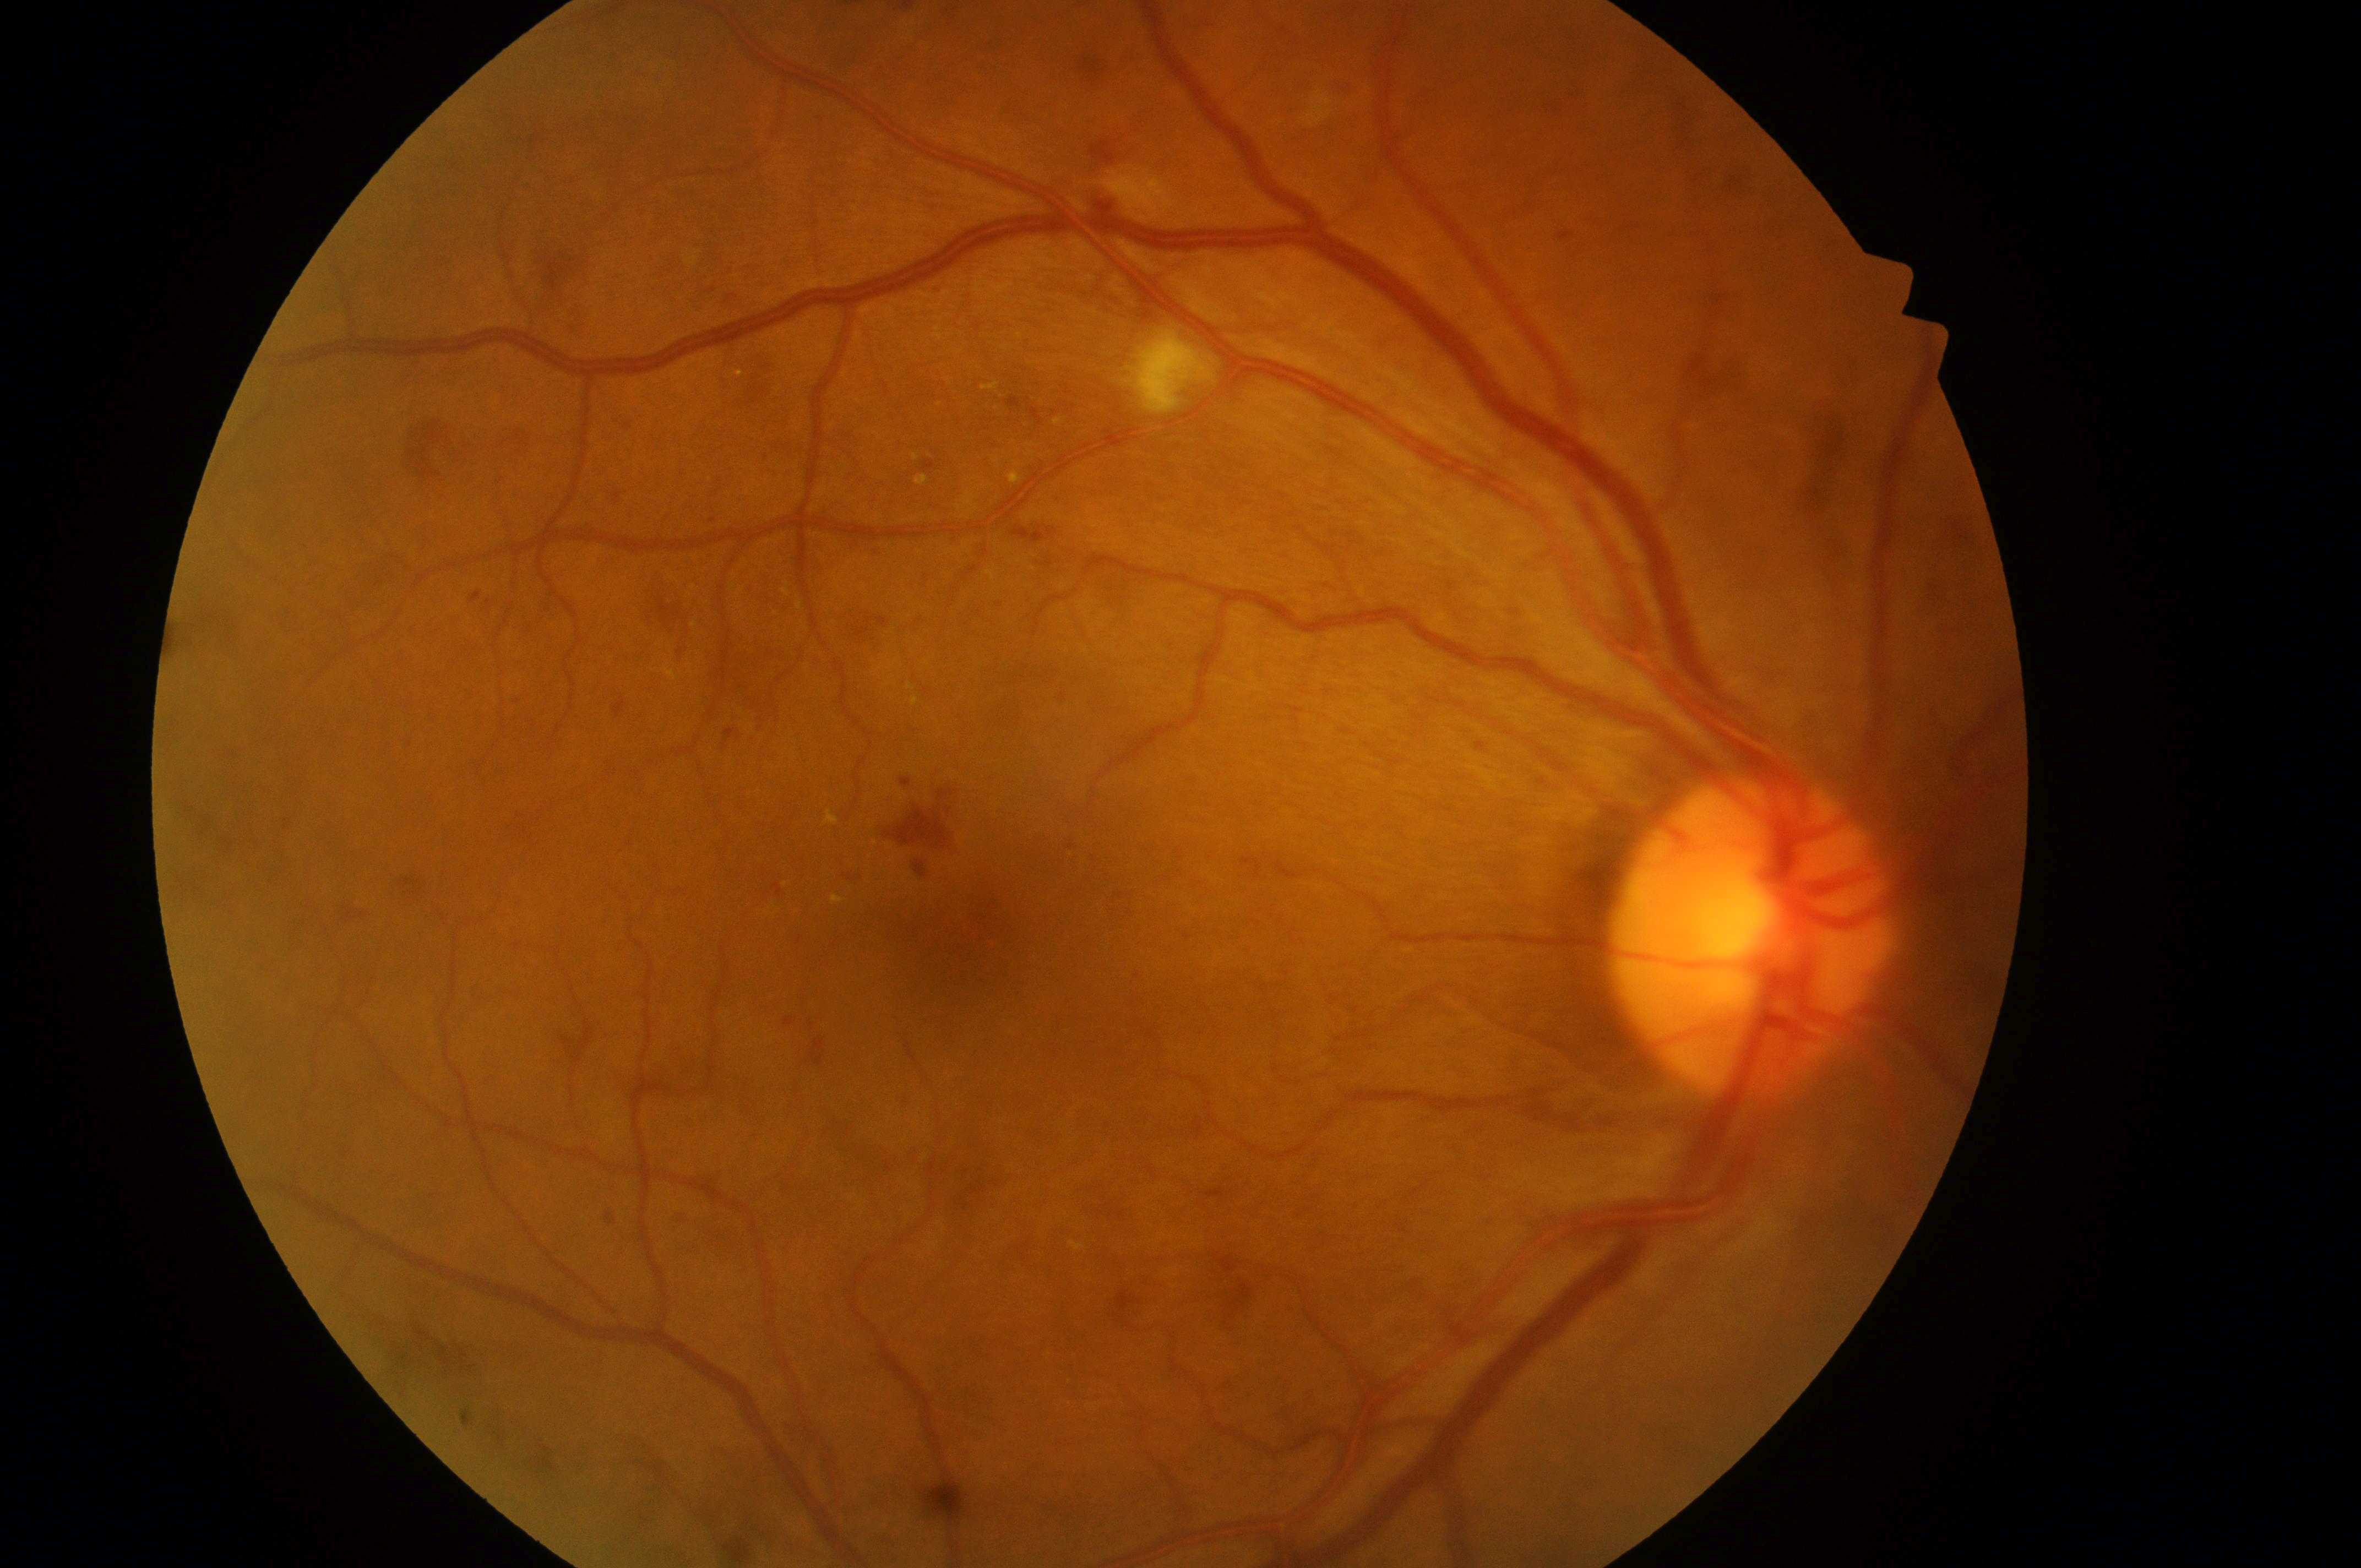
Imaged eye: OD.
Risk of diabetic macular edema: grade 2.
Disc center located at (x=1745, y=946).
DR class: non-proliferative diabetic retinopathy.
Fovea centralis located at (x=963, y=940).
Retinopathy is 2.